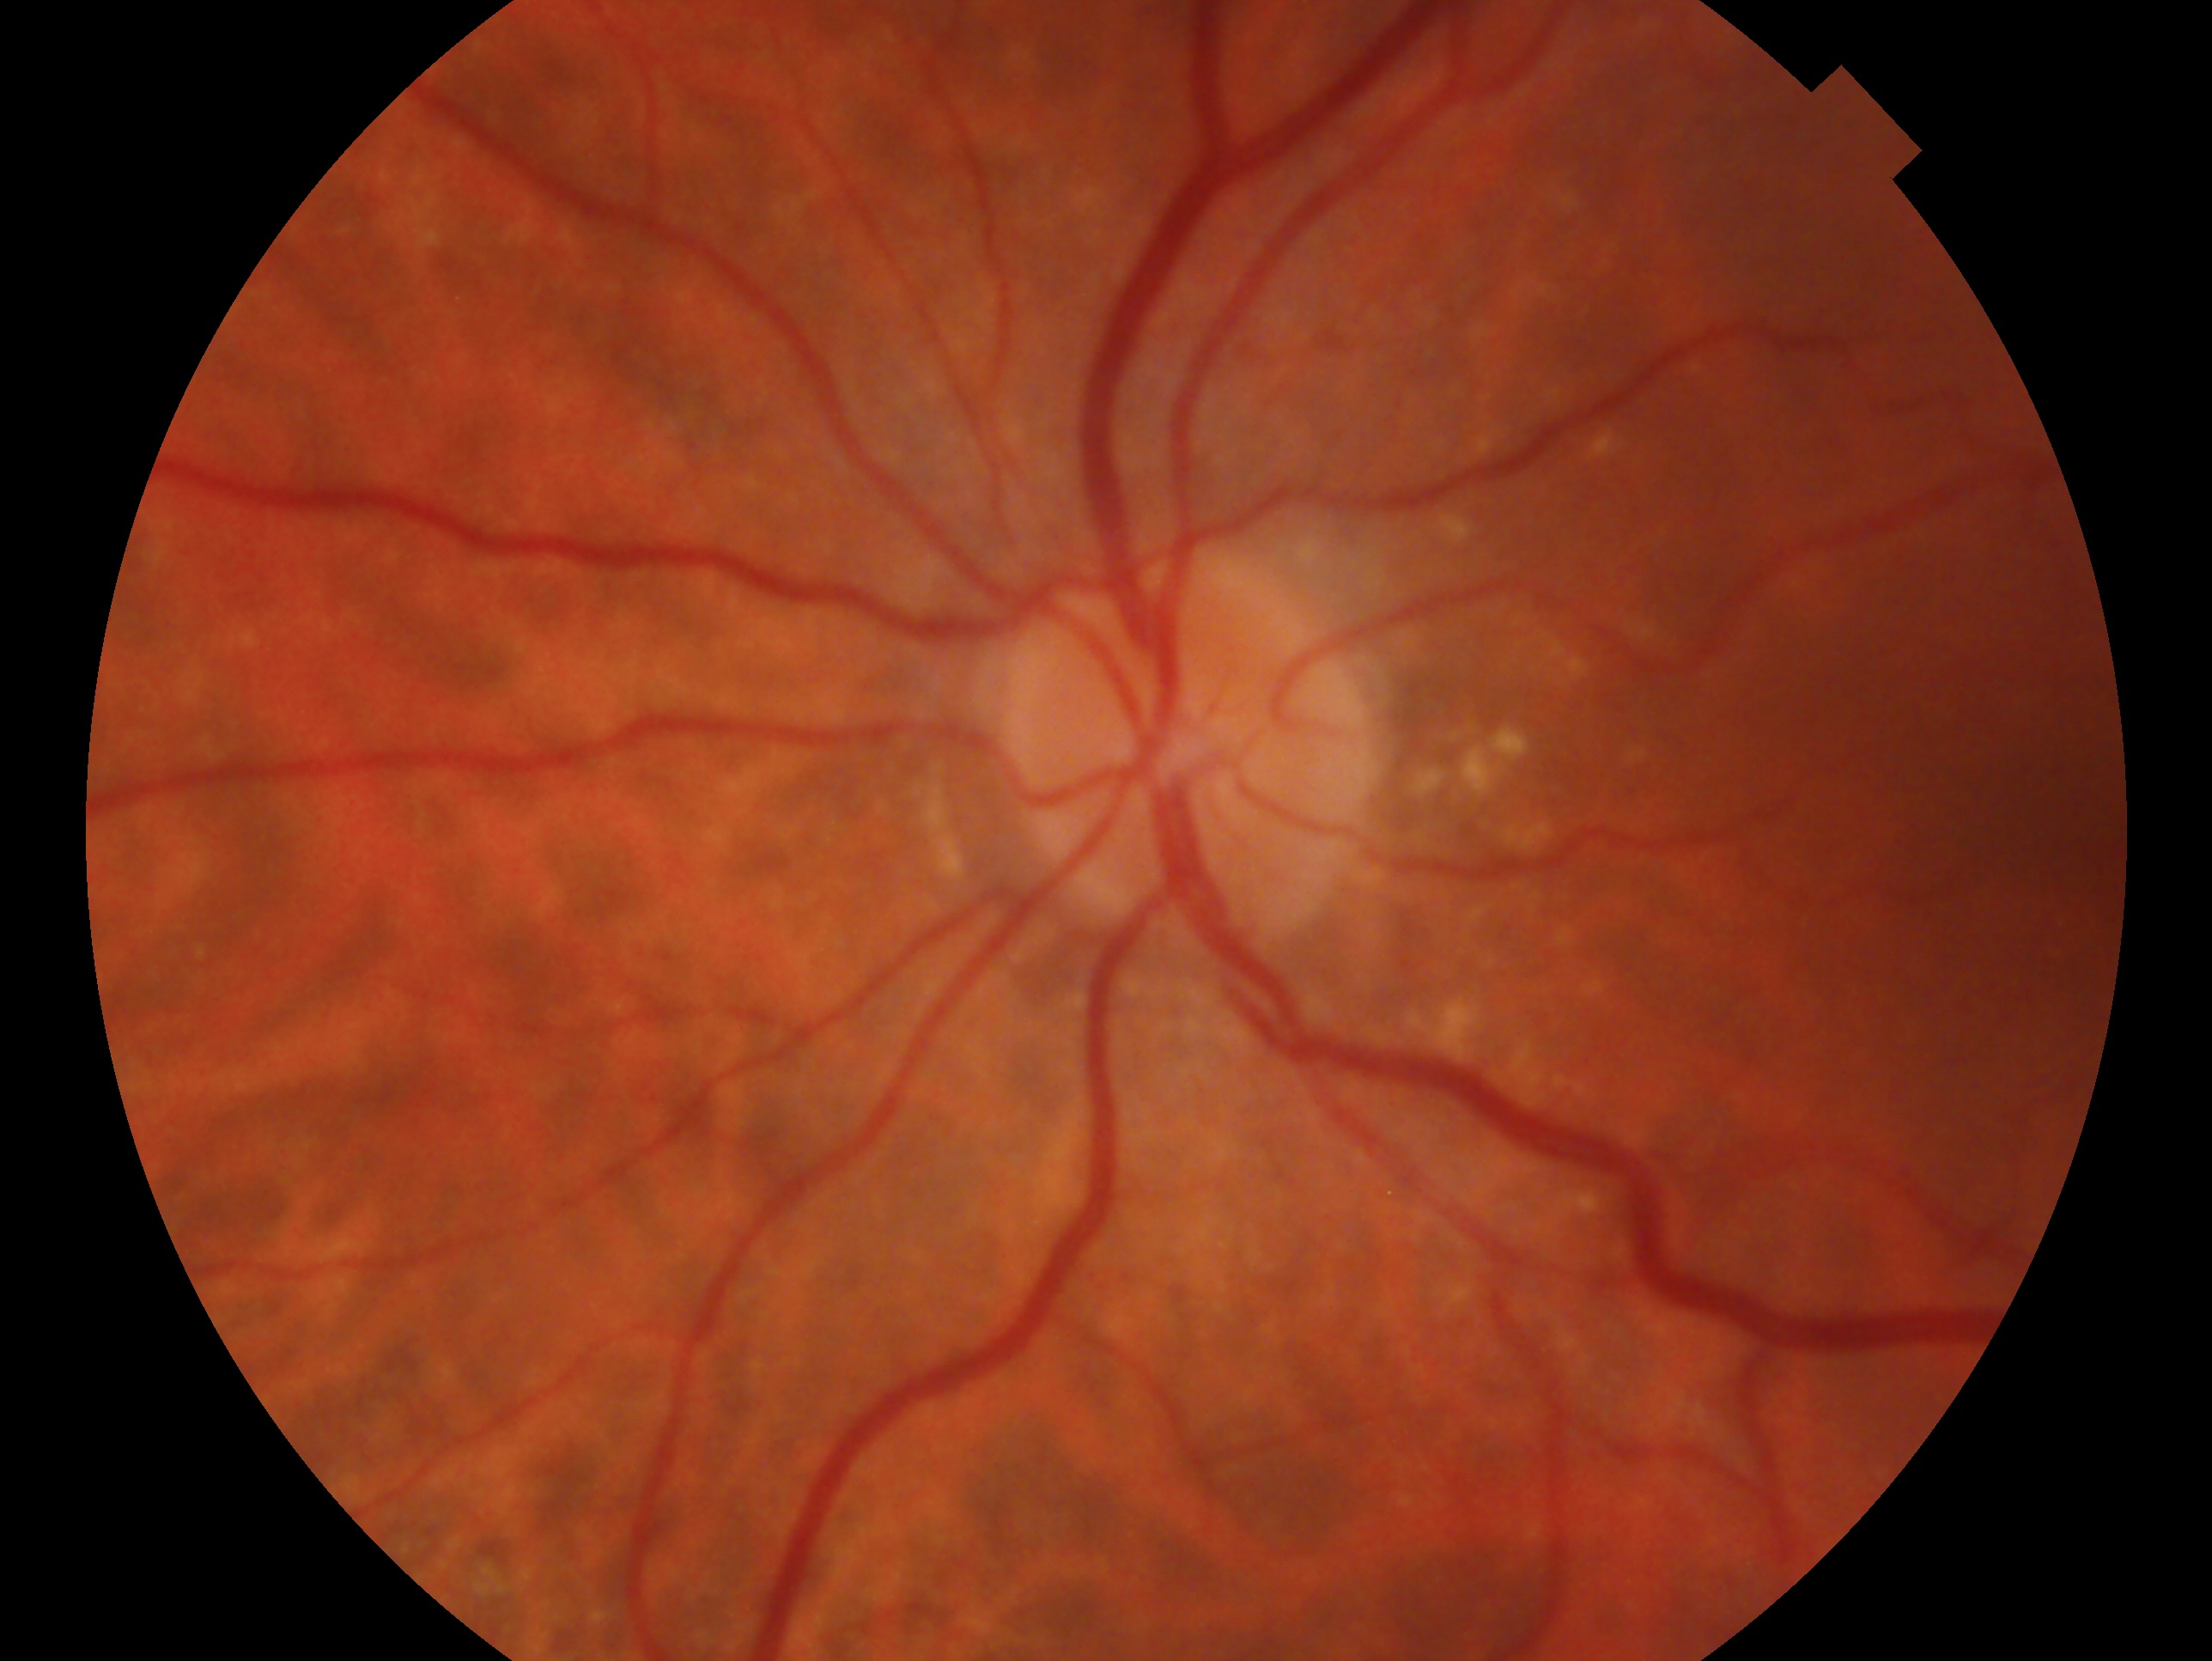 The image shows the oculus sinister.
Assessment: no signs of glaucoma.